Retinal fundus photograph, FOV: 45 degrees.
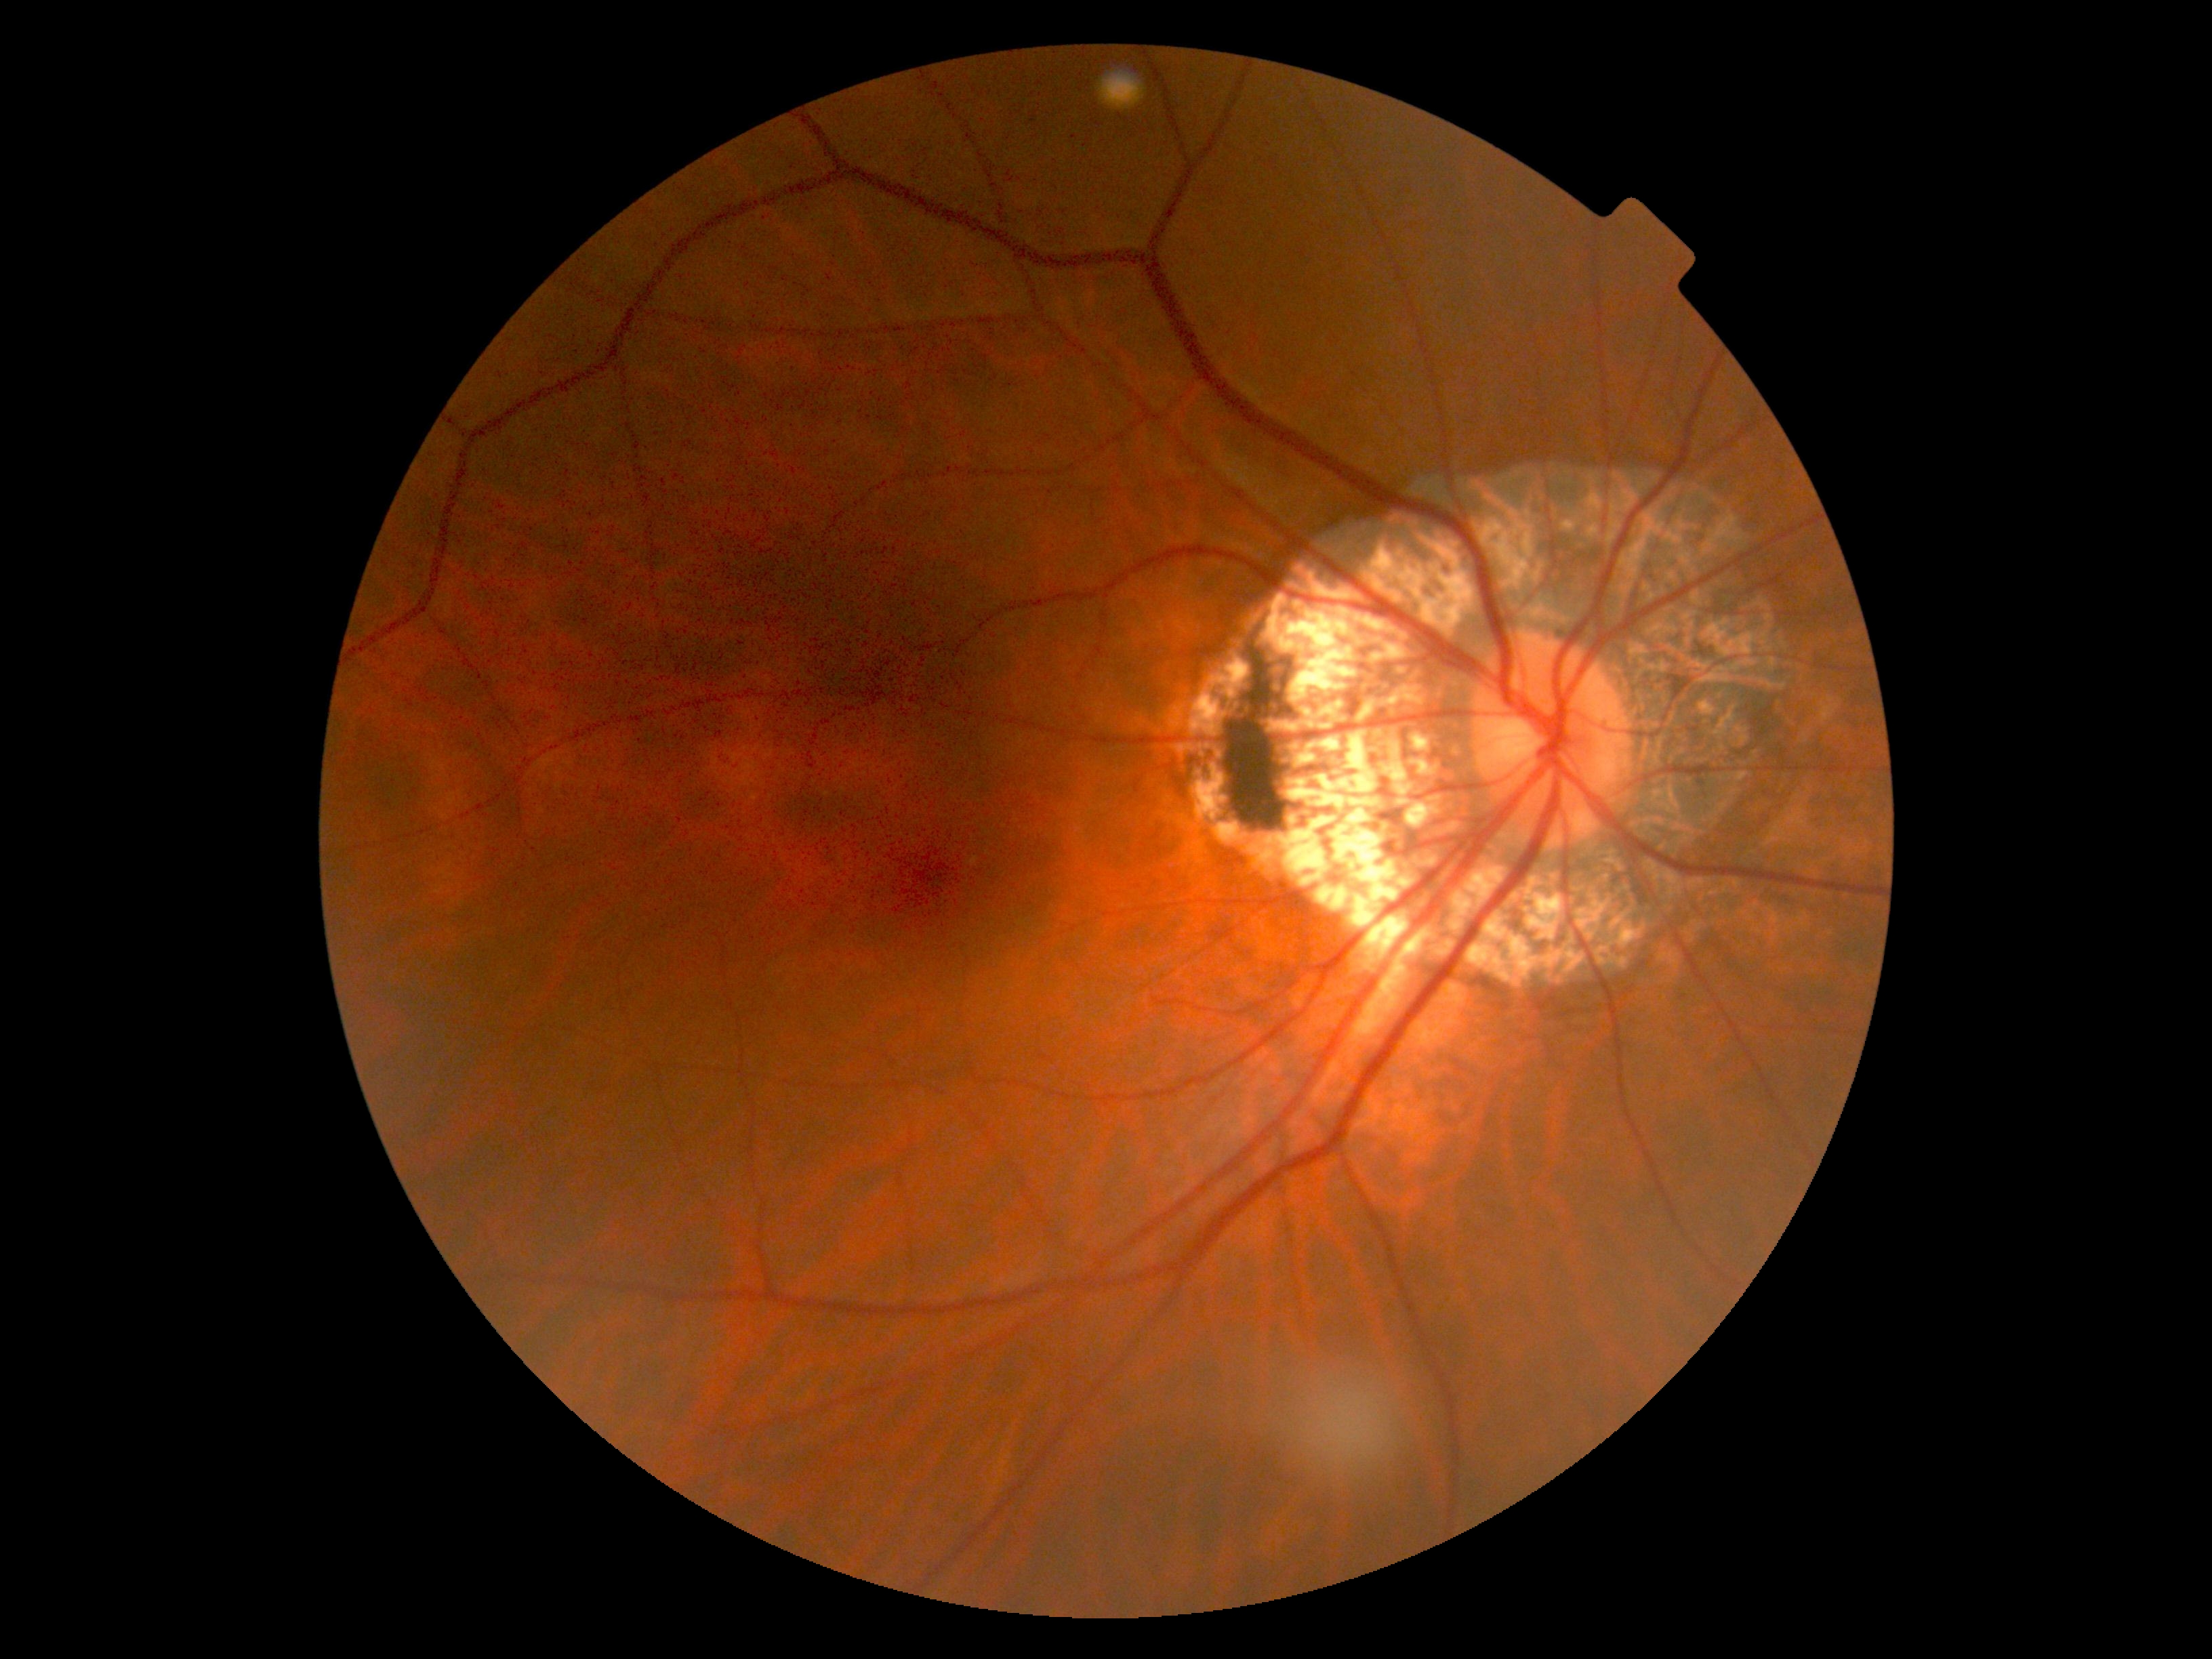 Diabetic retinopathy (DR) is 0. No signs of diabetic retinopathy.